640x480. RetCam wide-field infant fundus image — 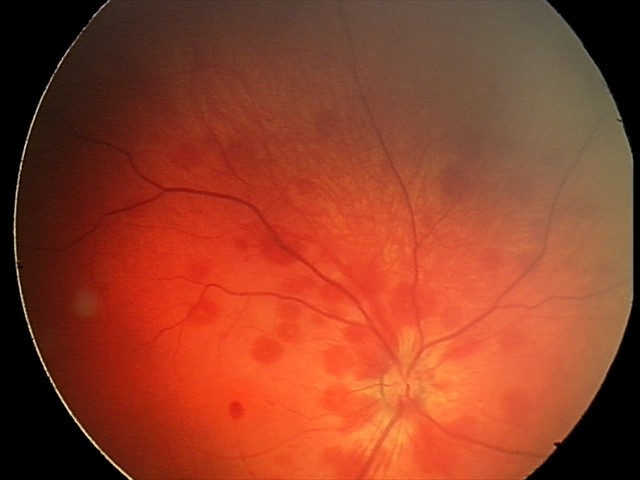

Screening diagnosis = retinal hemorrhages